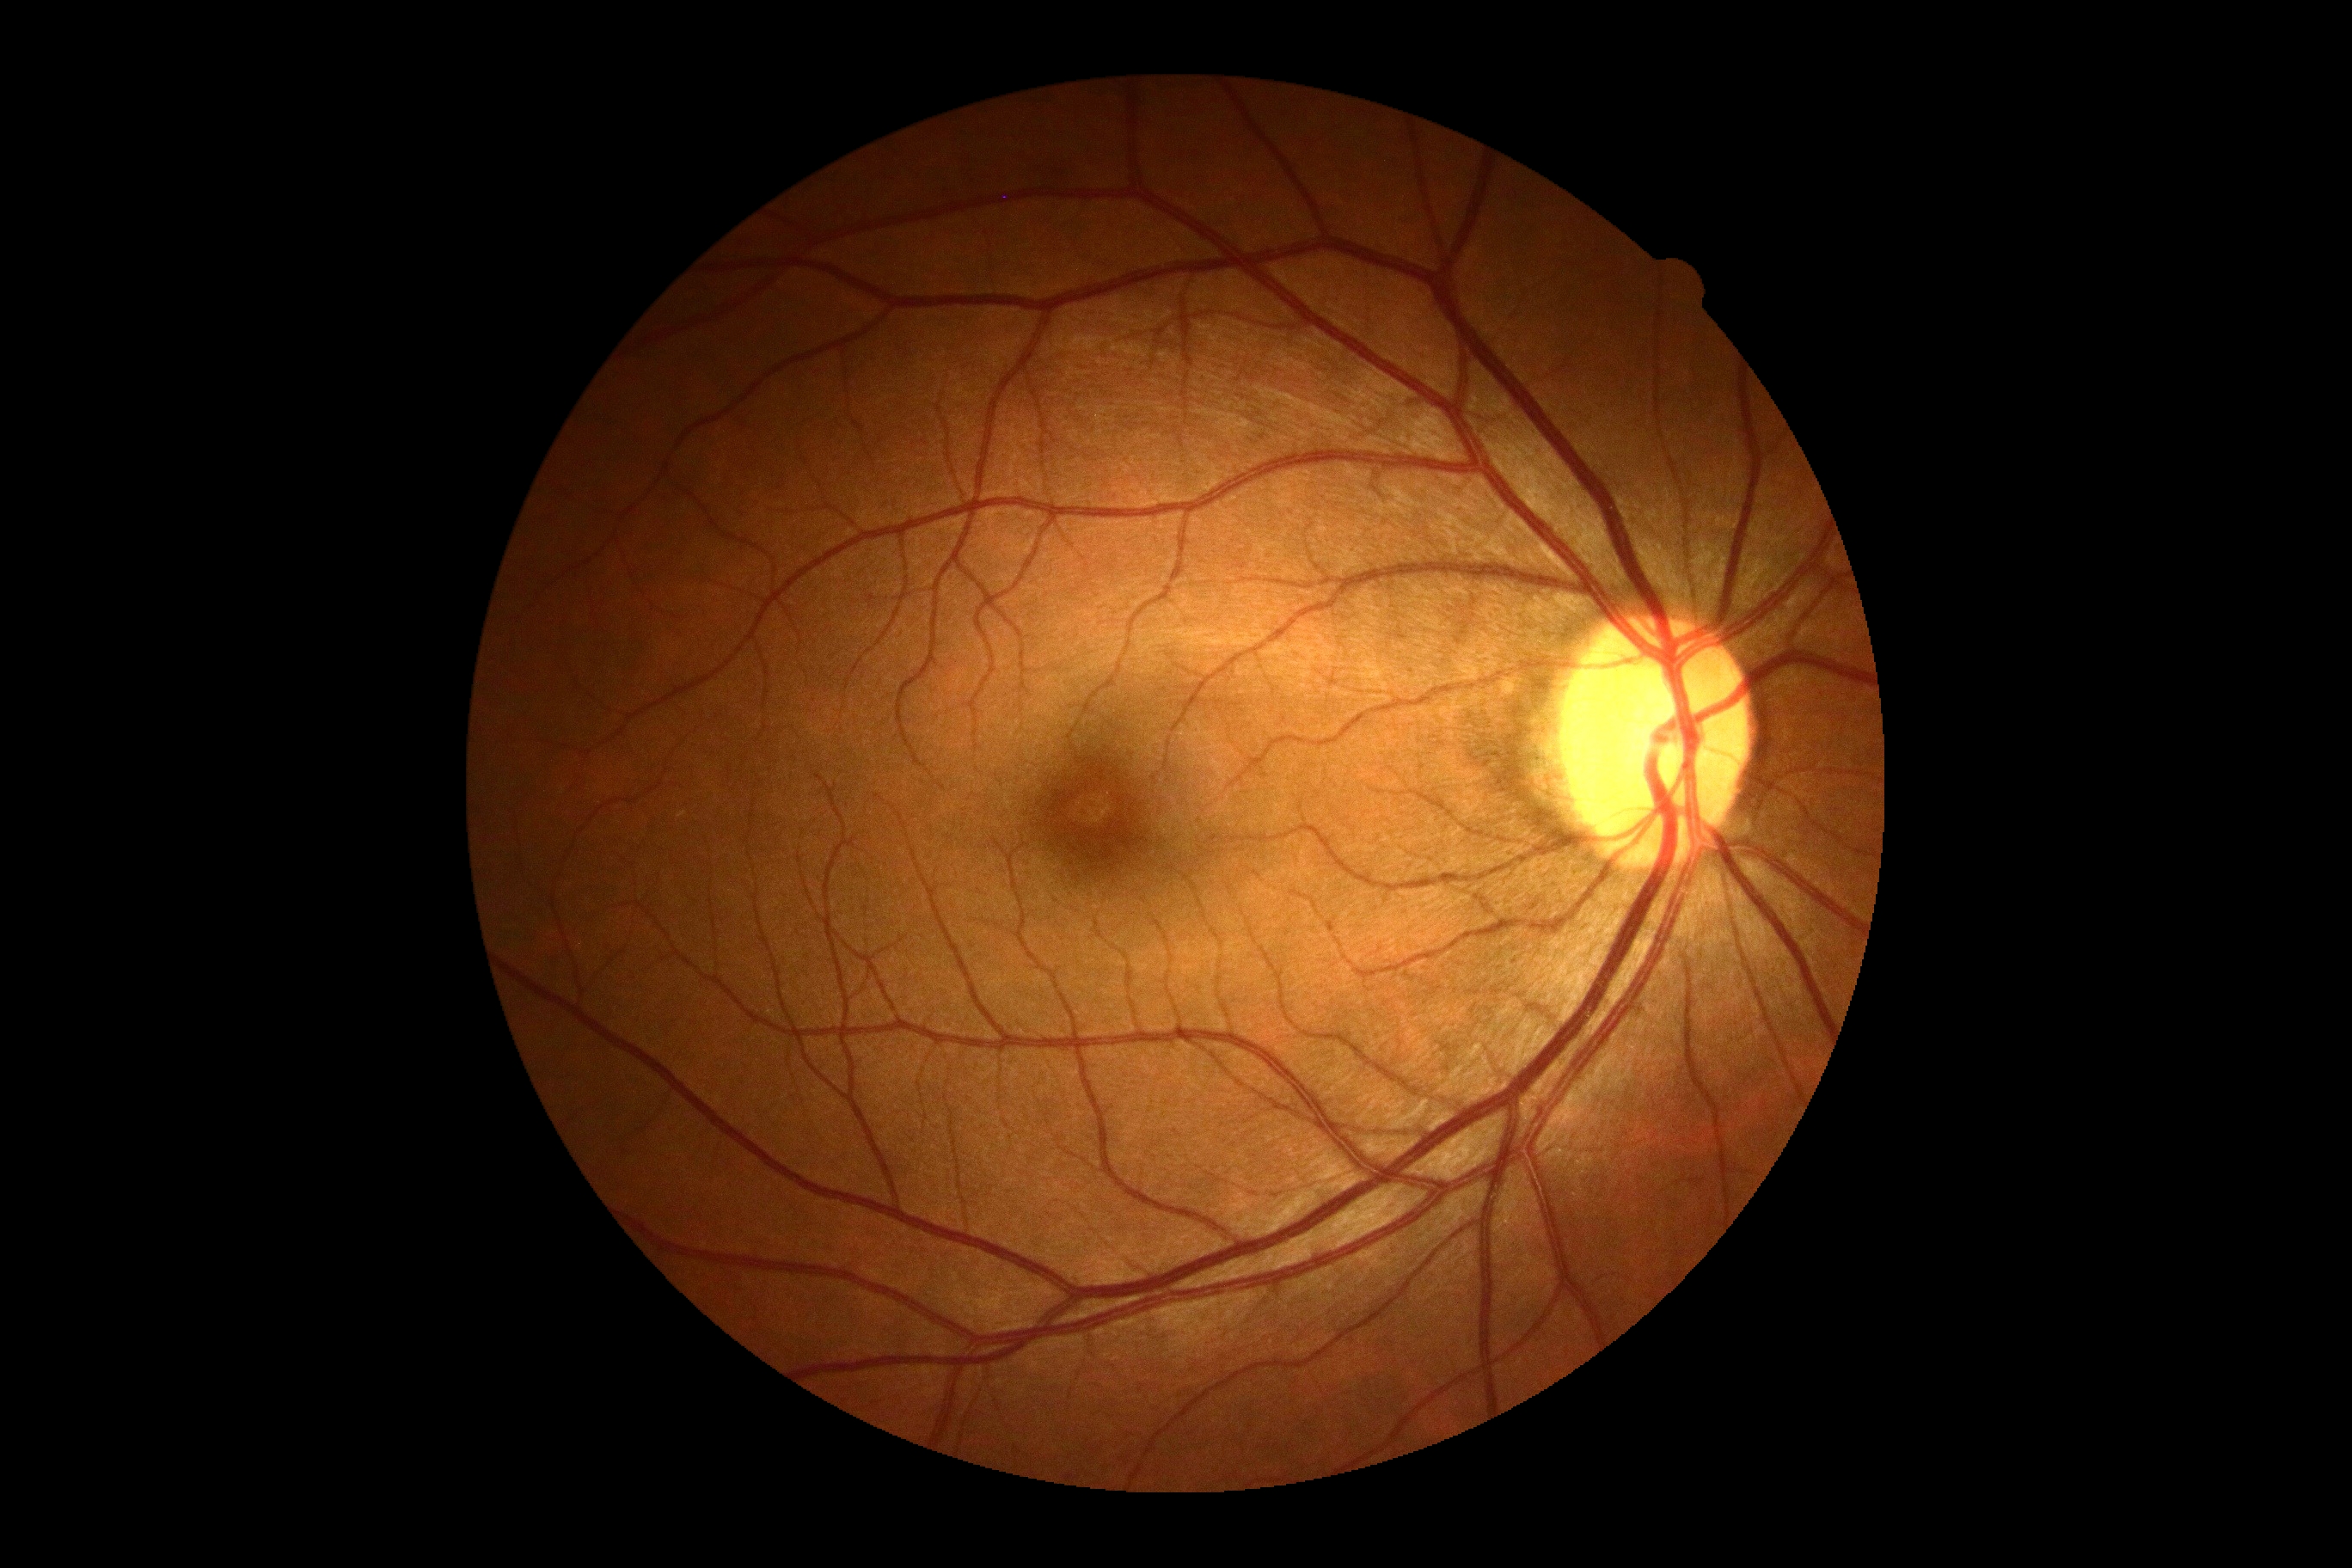
Findings:
- DR impression — no signs of DR
- DR grade — 0